1932 x 1916 pixels · CFP: 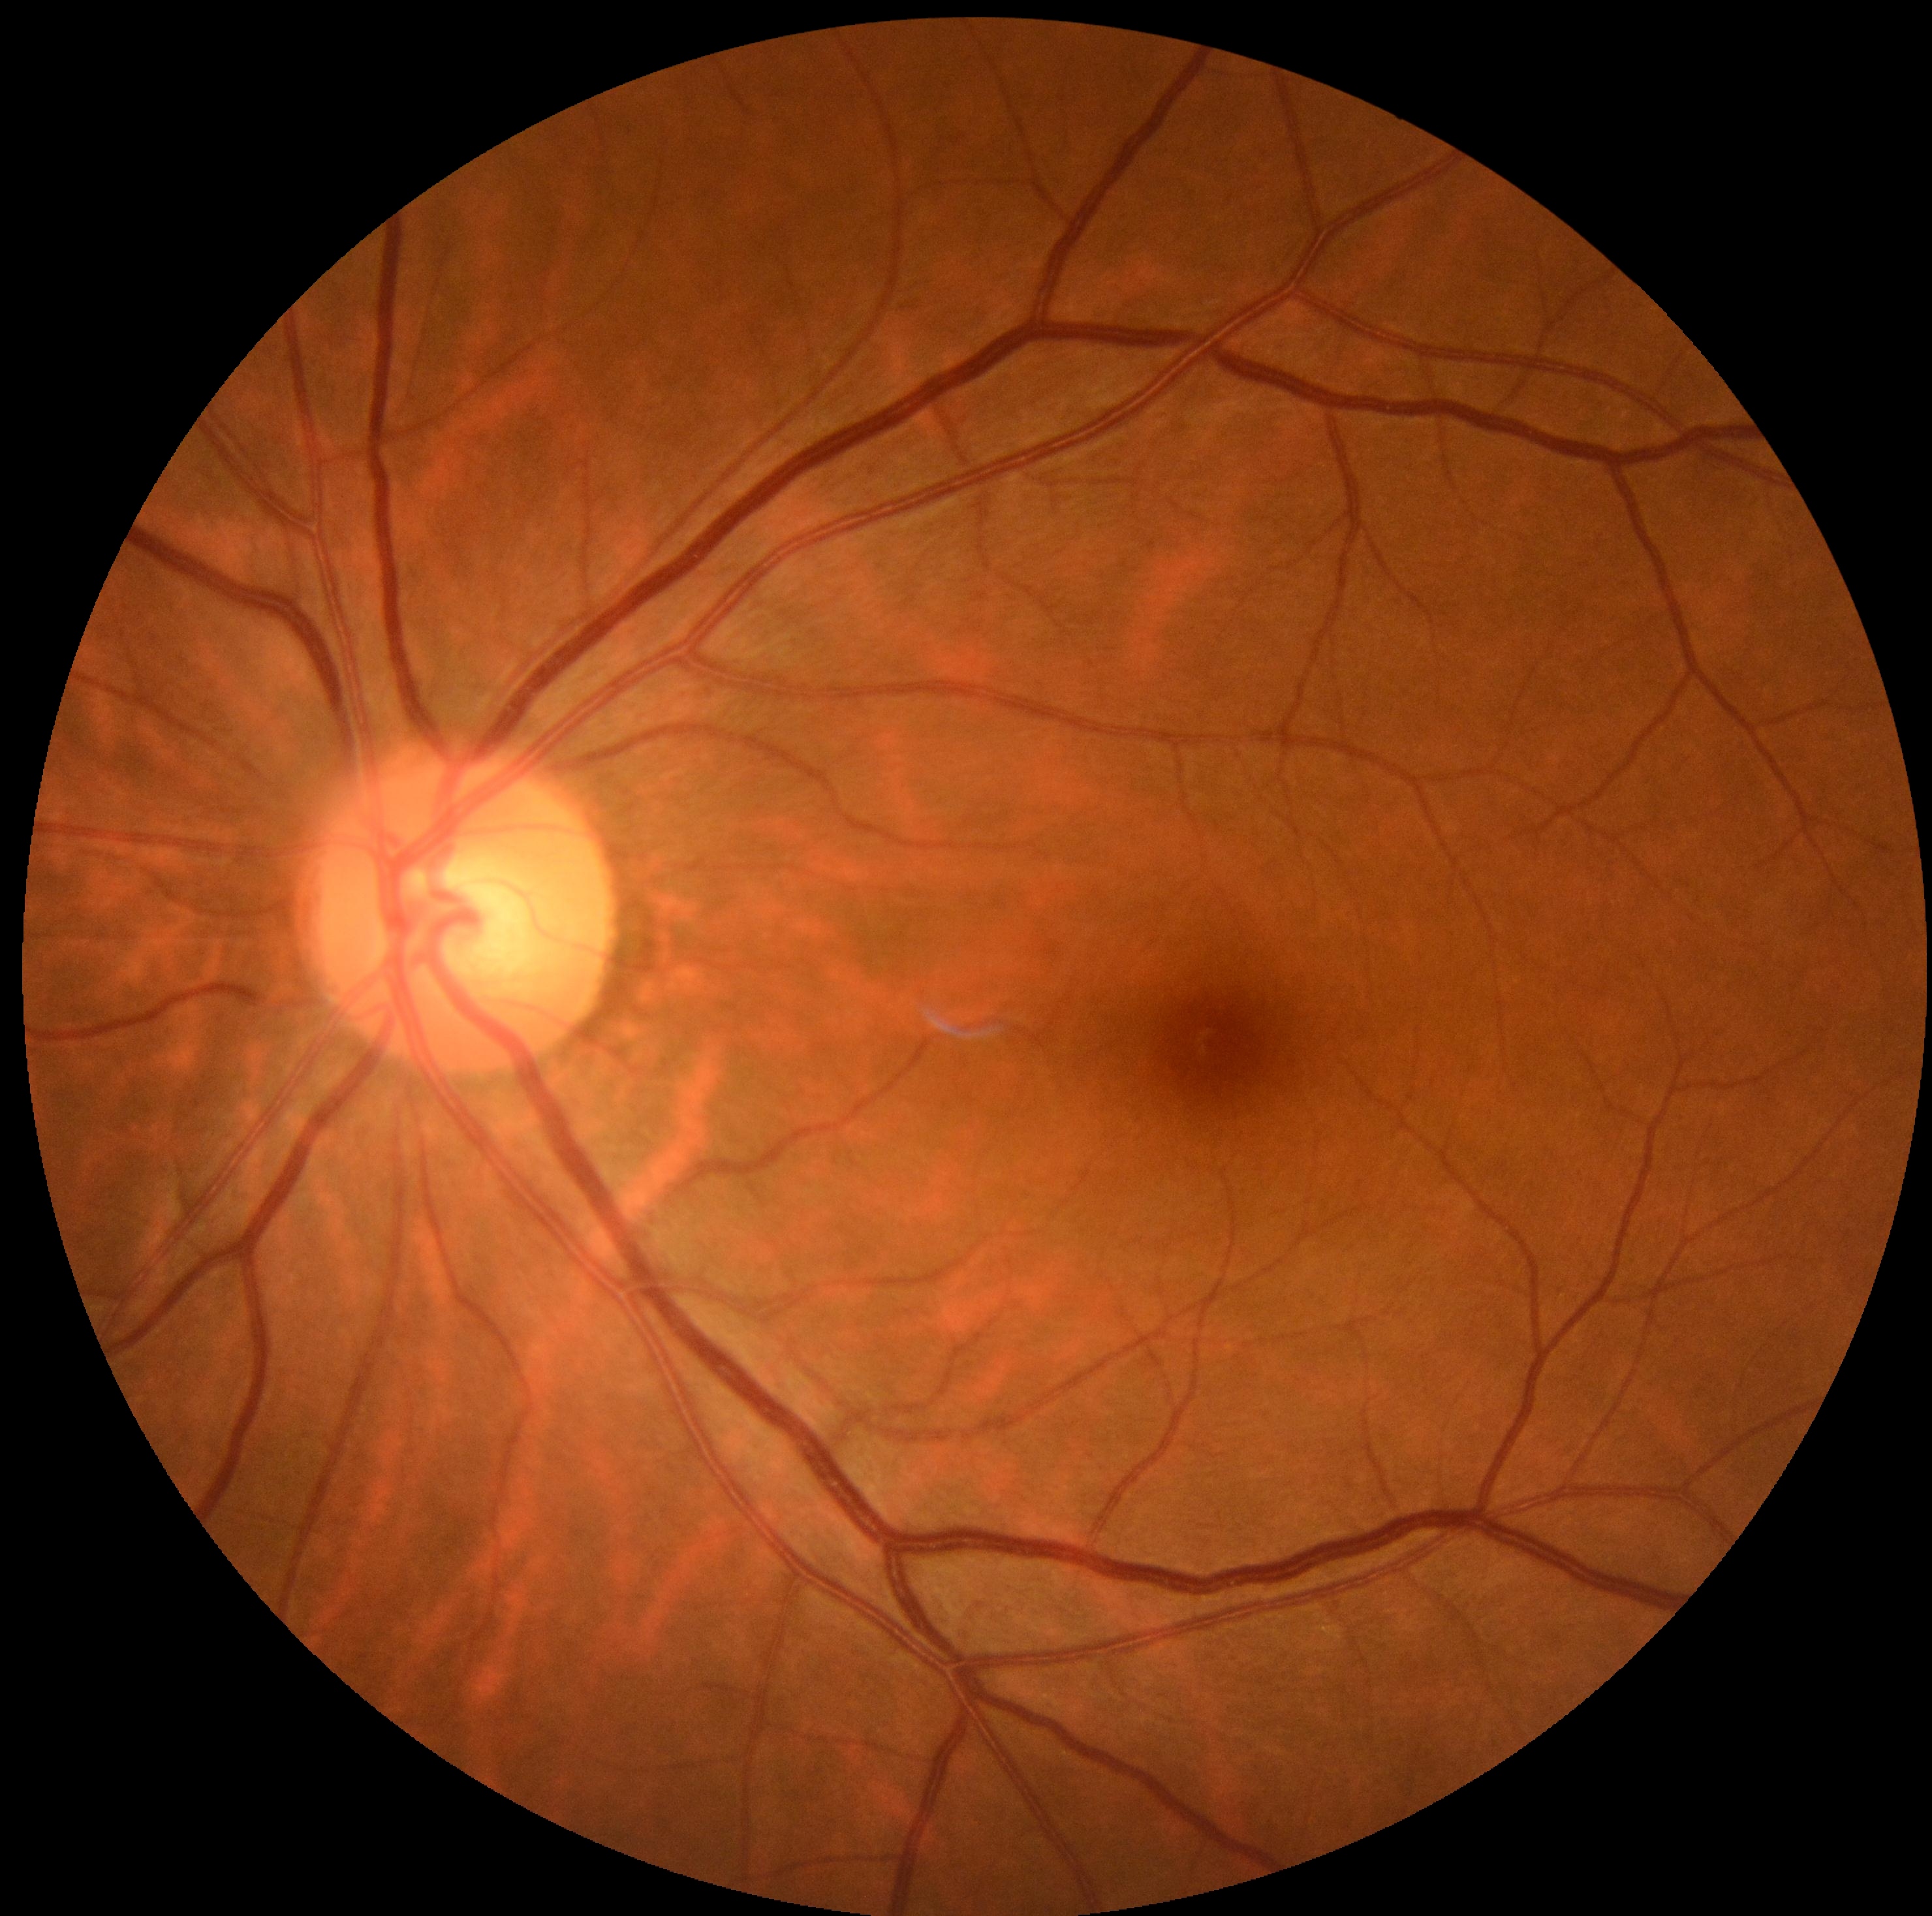

diabetic retinopathy grade = 0 (no apparent retinopathy)